Color fundus photograph · 848x848px · DR severity per modified Davis staging
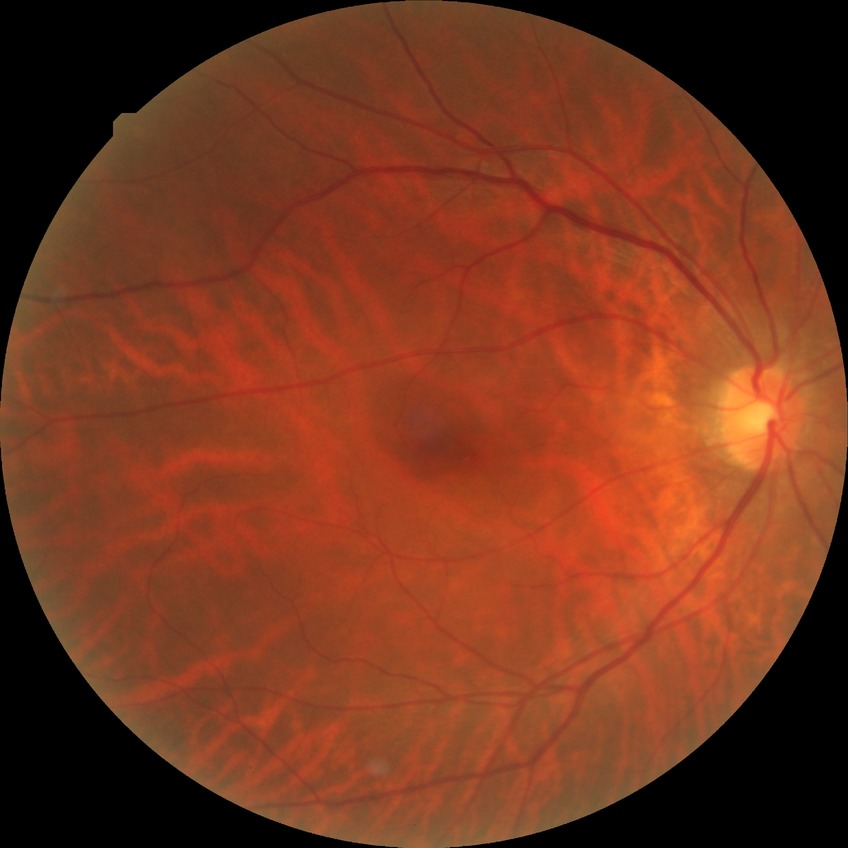
Diabetic retinopathy (DR) is NDR (no diabetic retinopathy).